Acquired on the Clarity RetCam 3. Wide-field fundus photograph from neonatal ROP screening.
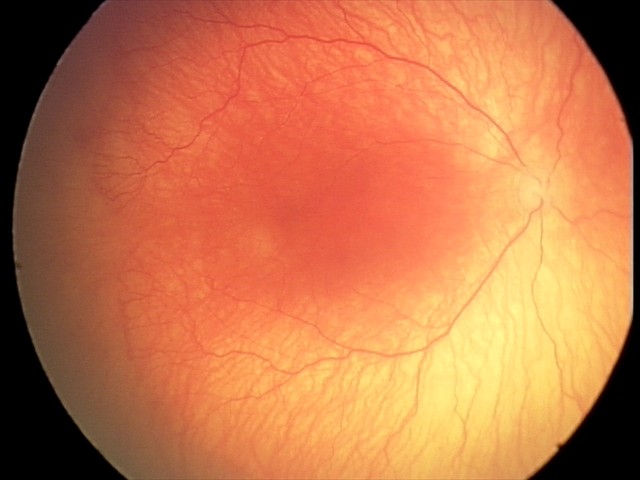
Plus disease present. Series diagnosed as aggressive retinopathy of prematurity (A-ROP).